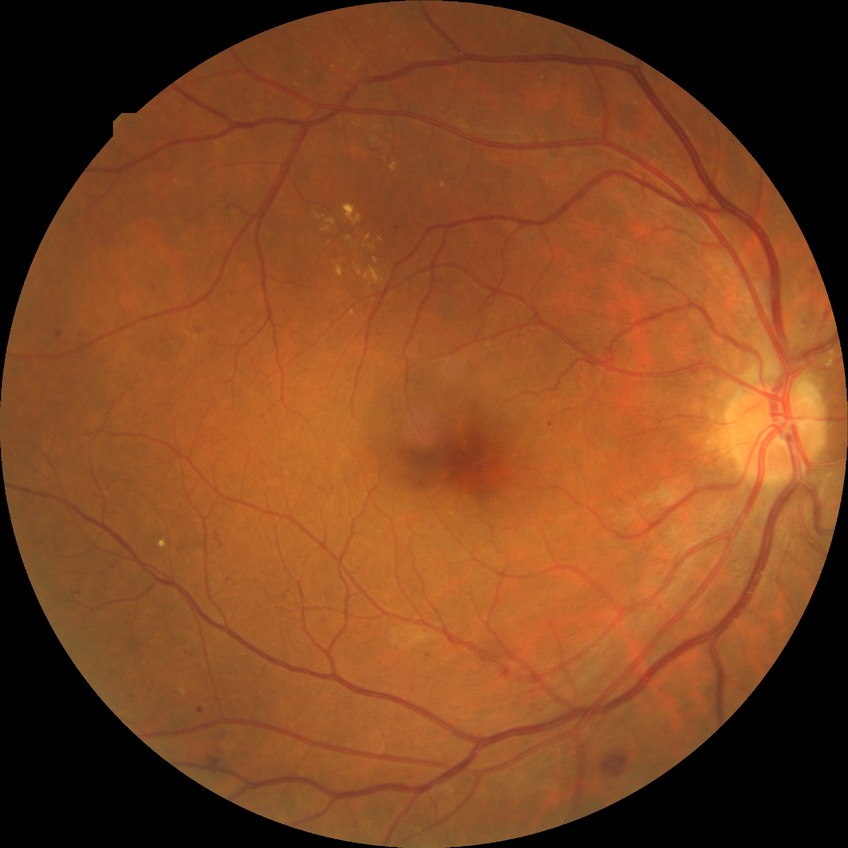 Disease class: non-proliferative diabetic retinopathy. Diabetic retinopathy (DR) is PPDR (pre-proliferative diabetic retinopathy).